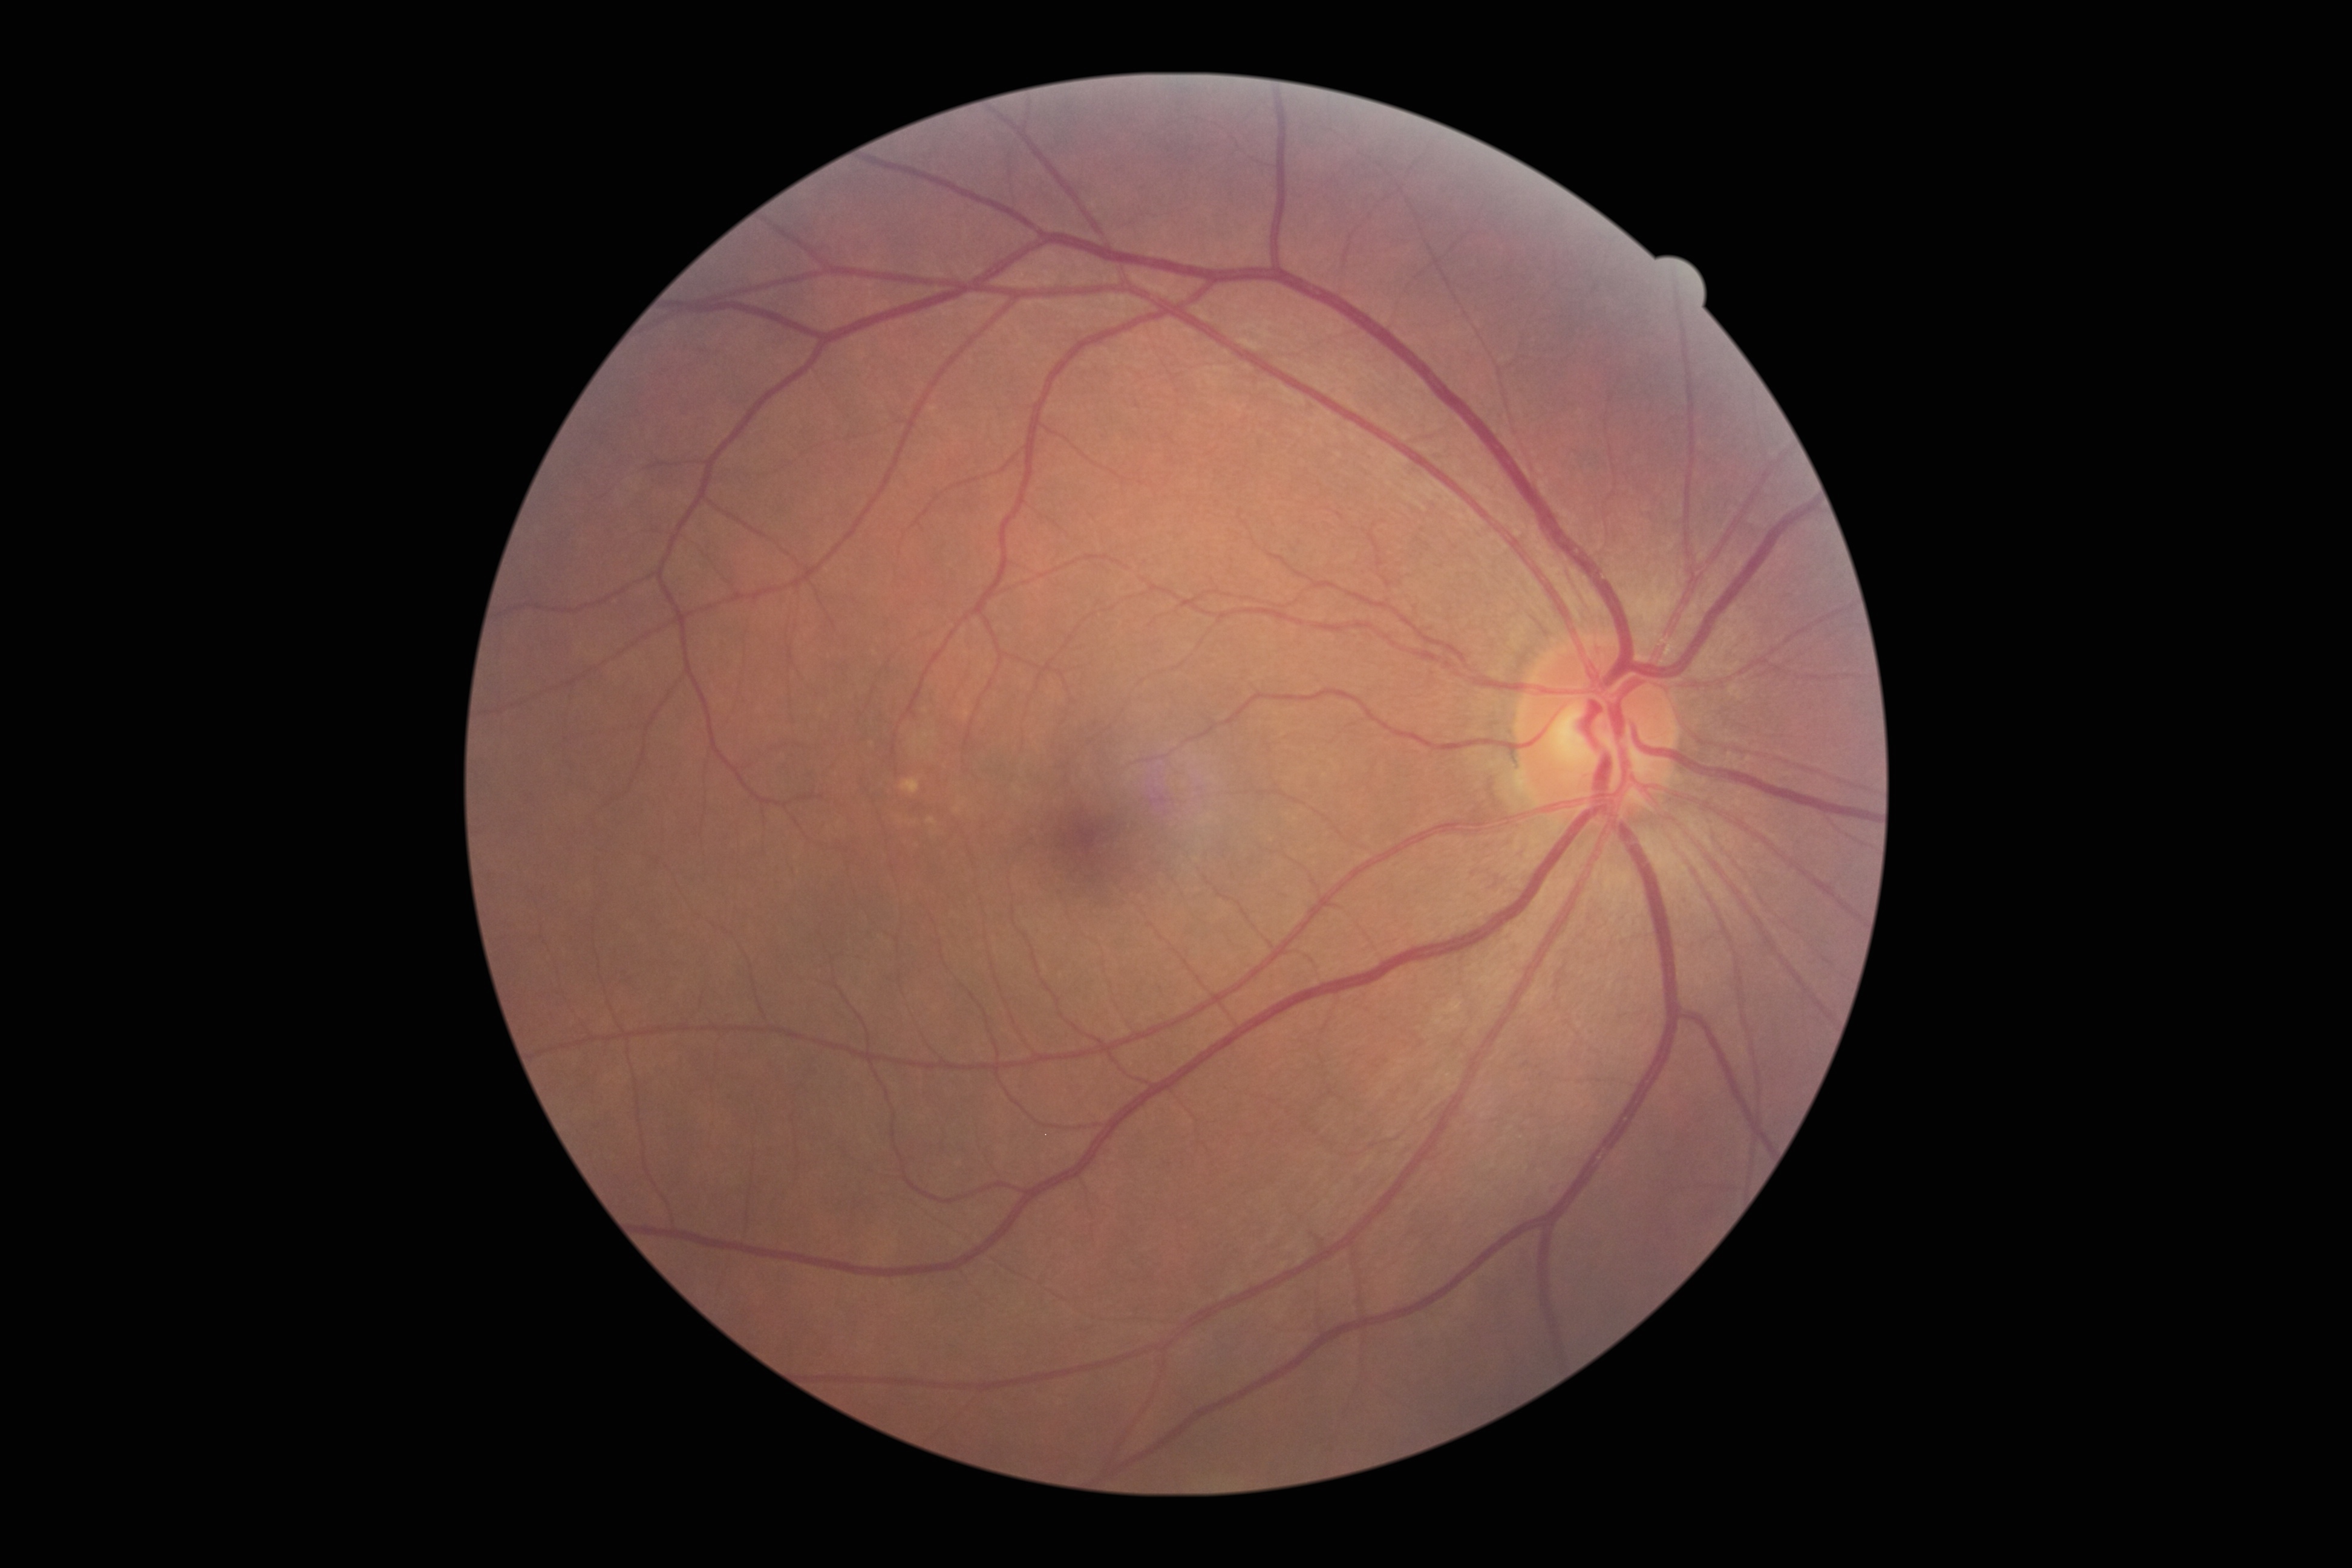

DR severity: no apparent diabetic retinopathy (grade 0). No diabetic retinal disease findings.